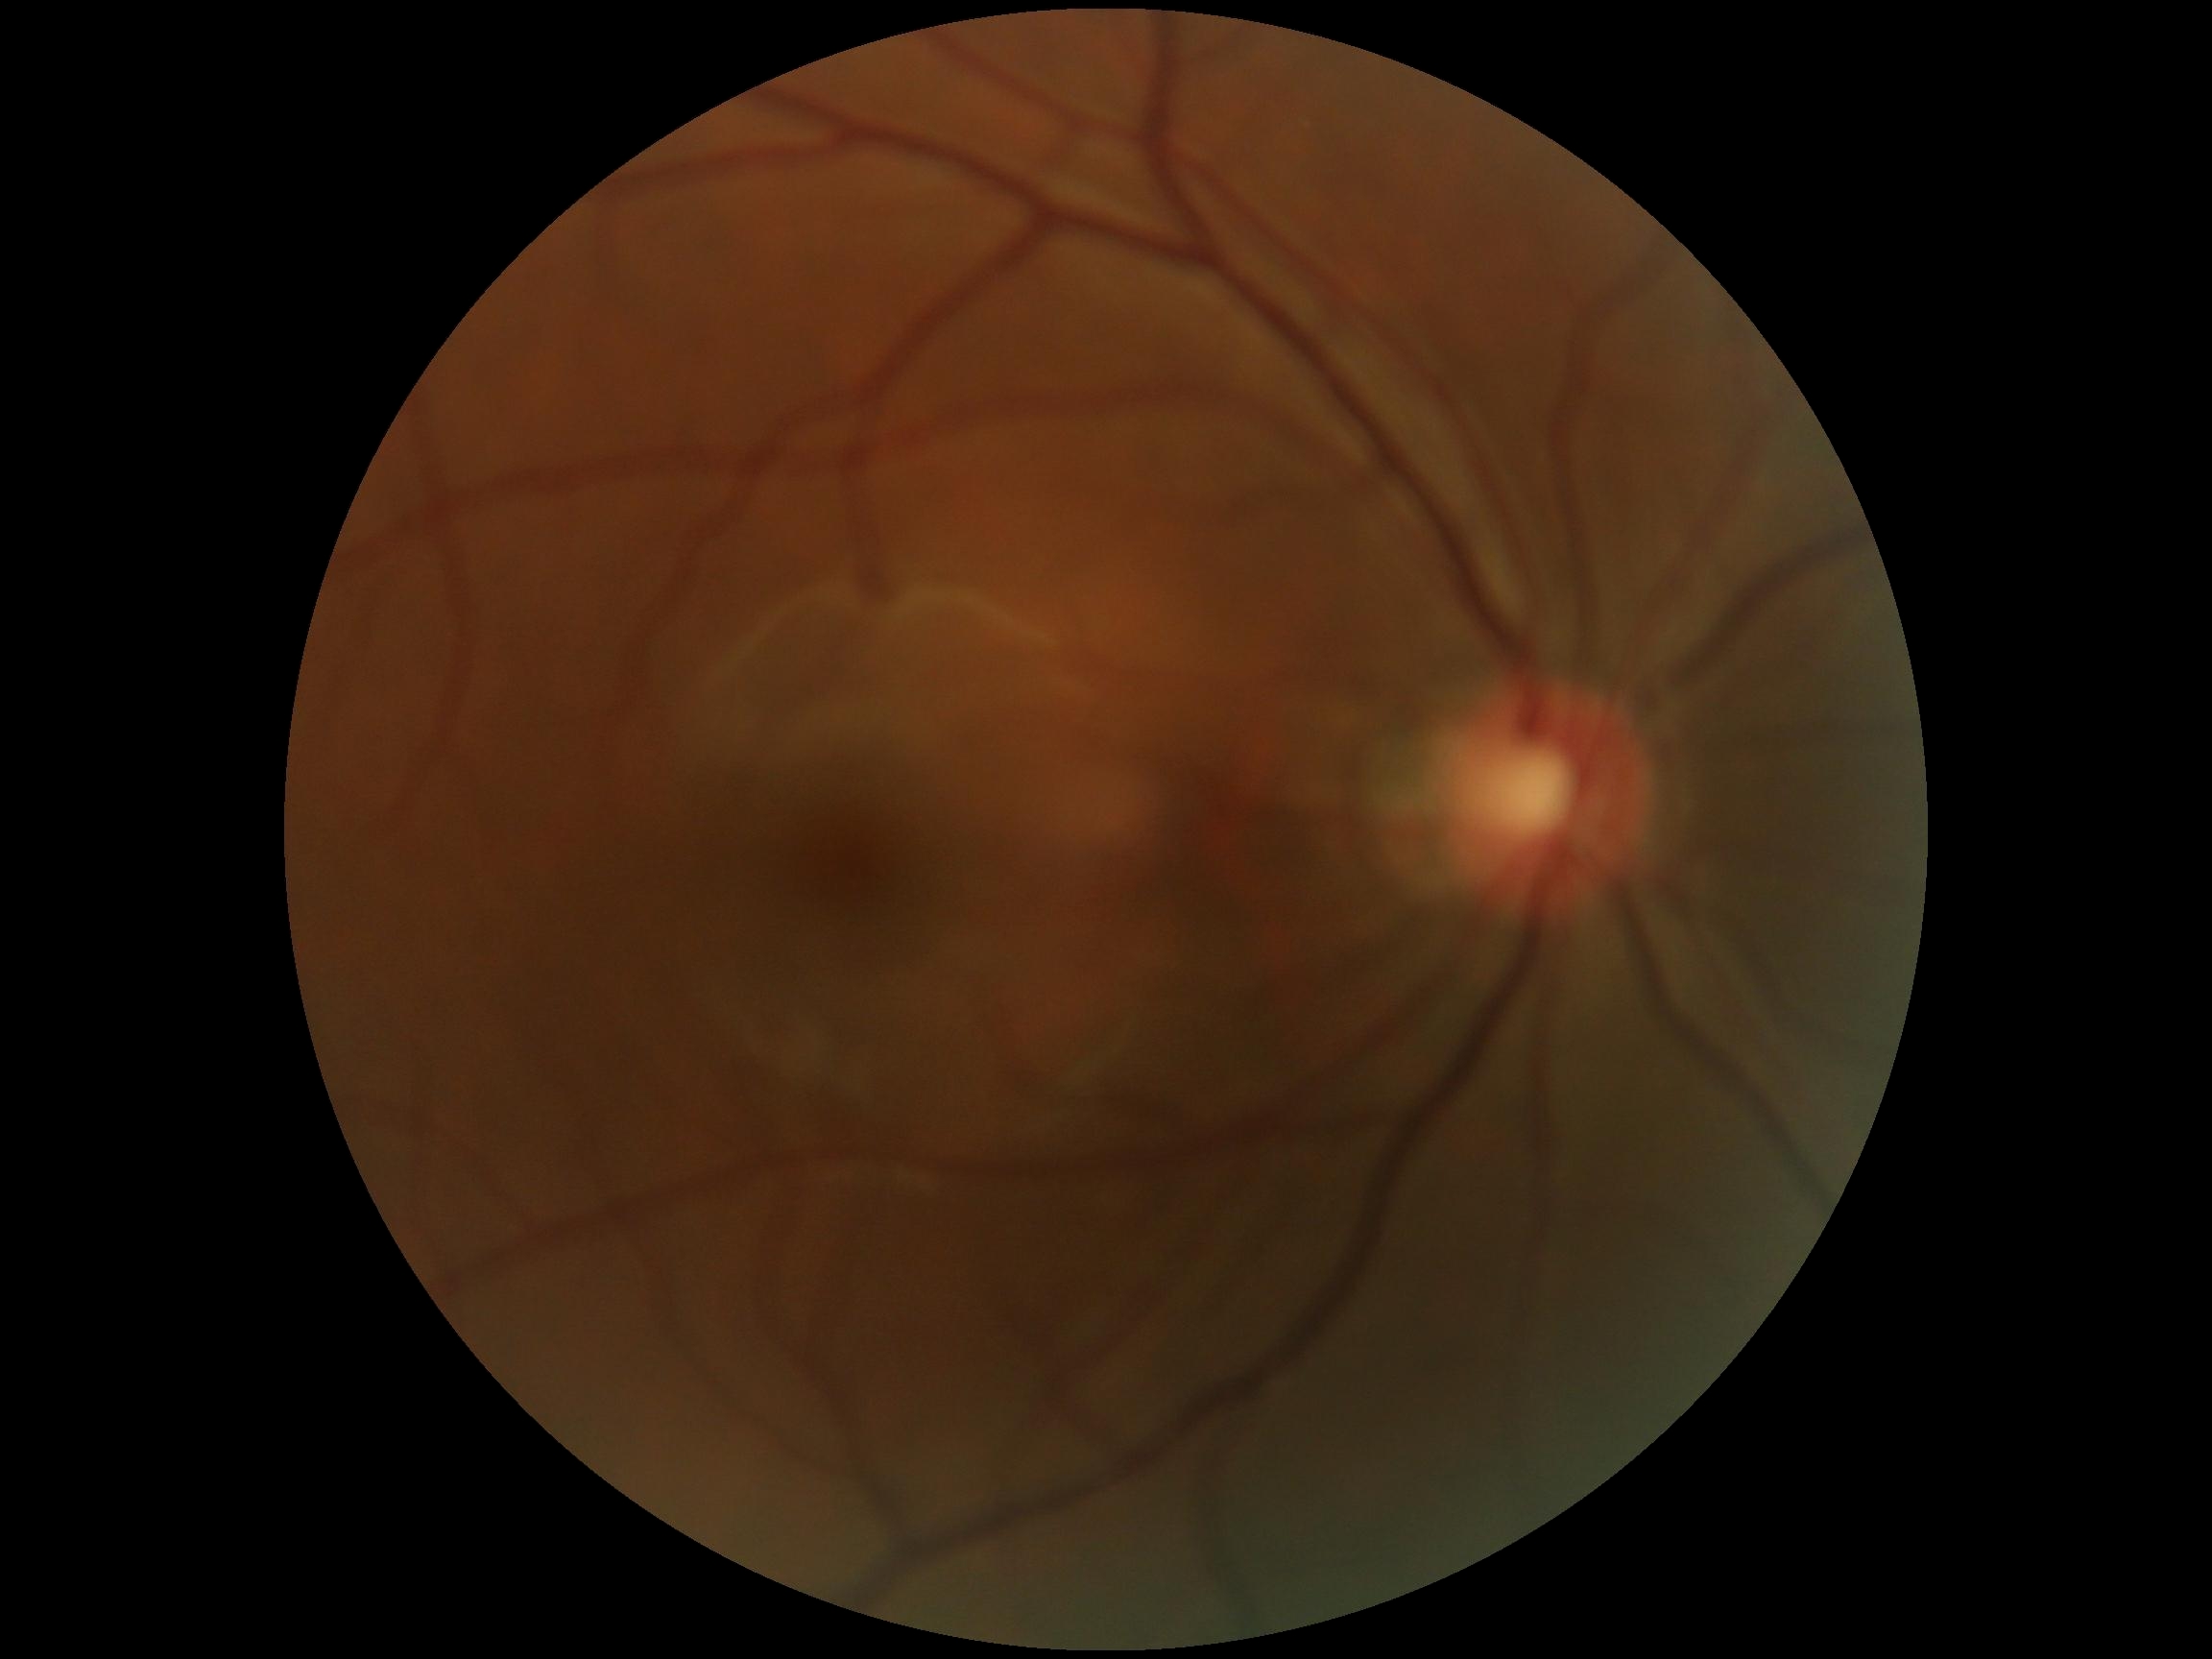
No DR findings. Diabetic retinopathy is grade 0 (no apparent retinopathy).